Wide-field fundus image from infant ROP screening · image size 640x480 · 130° field of view (Clarity RetCam 3) — 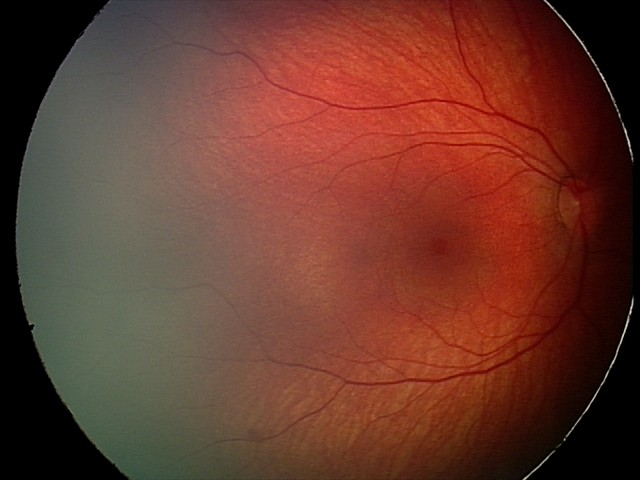

Q: What was the screening finding?
A: retinal hemorrhages